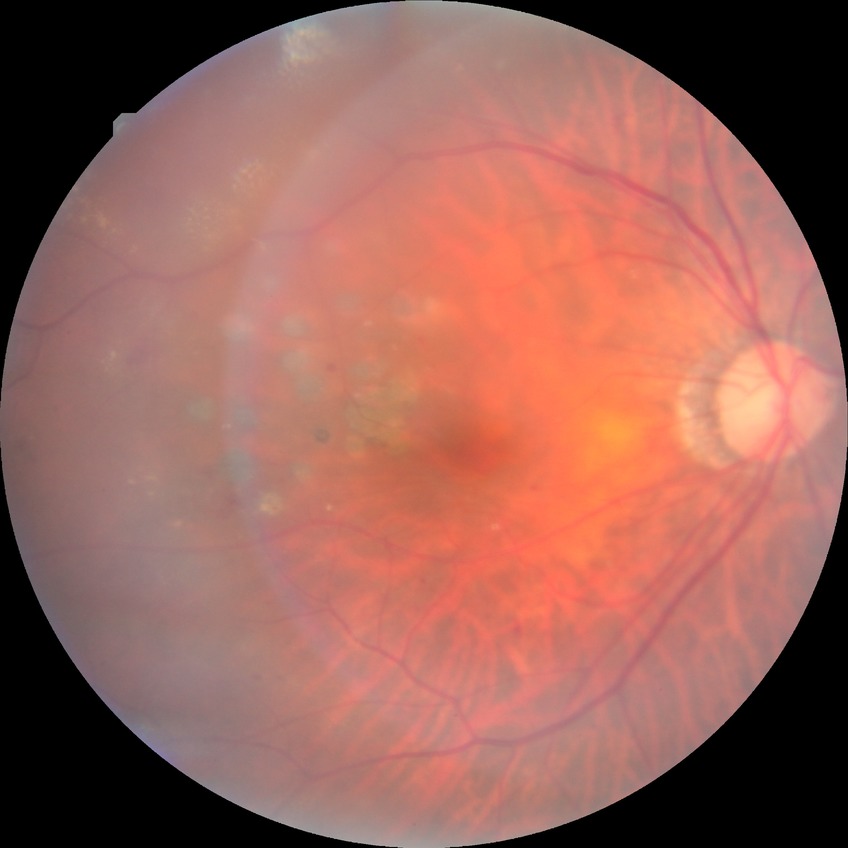 Diabetic retinopathy (DR): proliferative diabetic retinopathy (PDR).